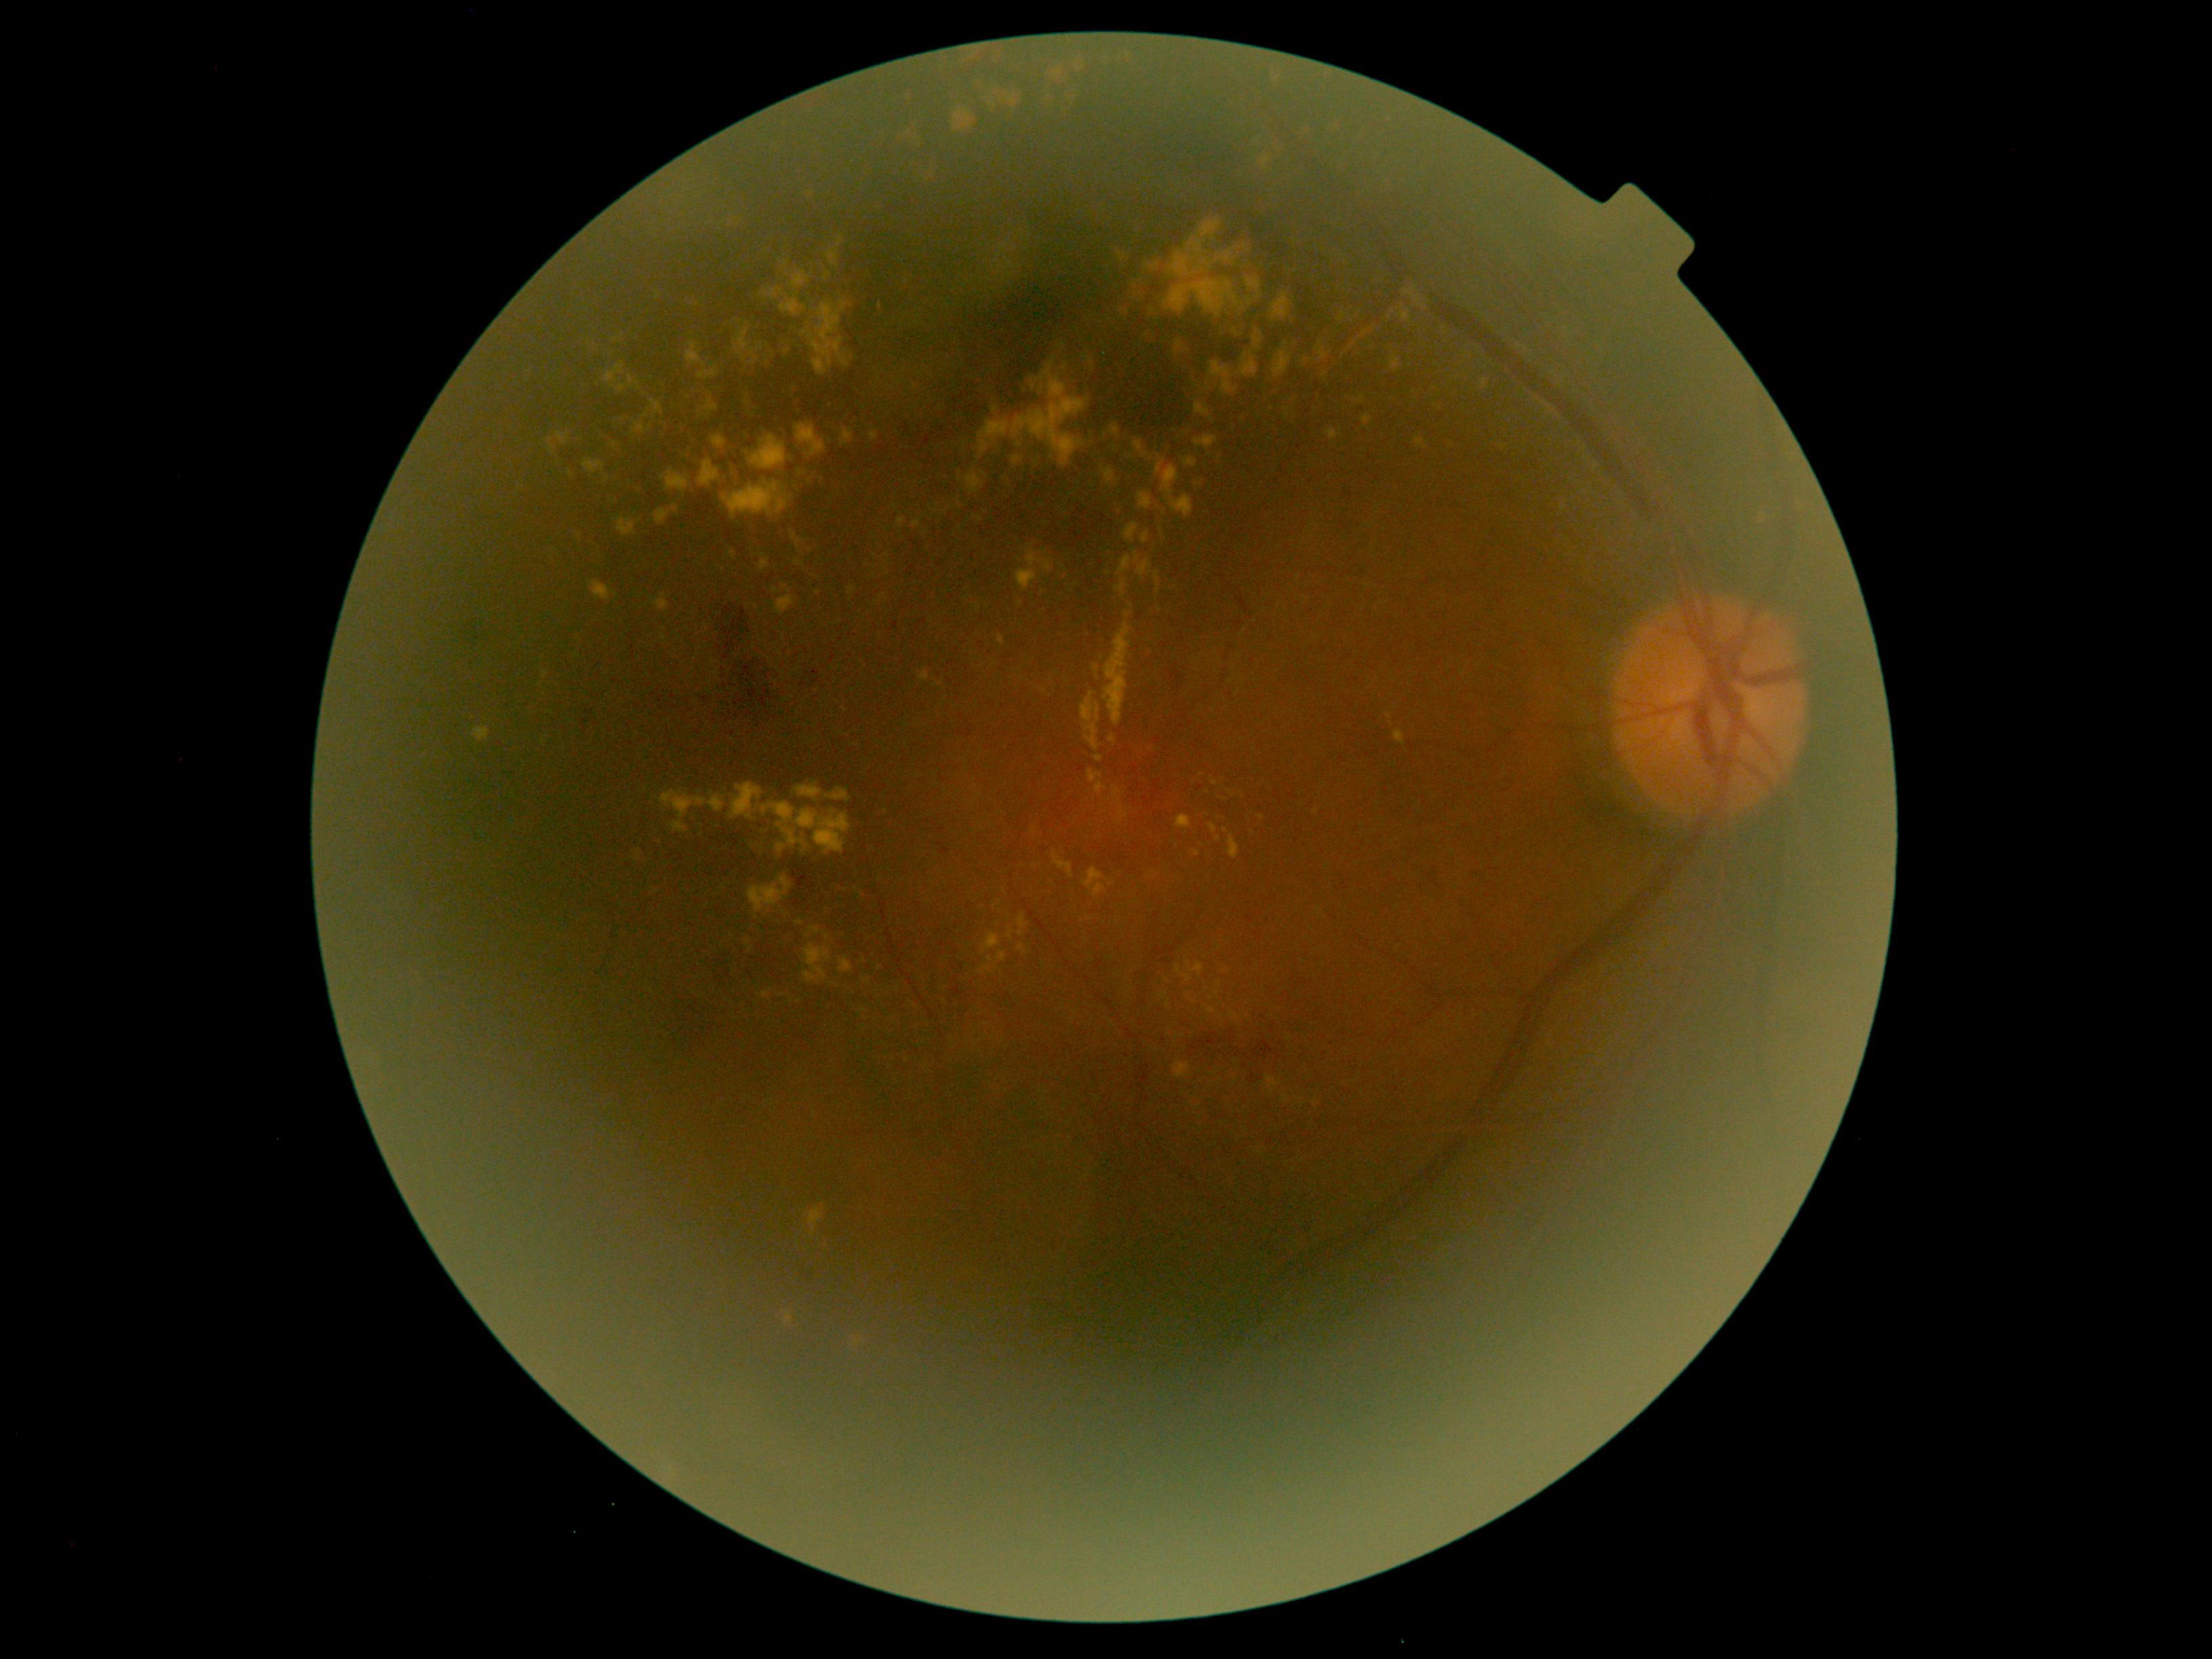 DR: 2/4
Representative lesions:
EXs (continued): (left=1193, top=434, right=1219, bottom=449), (left=704, top=626, right=710, bottom=634), (left=1230, top=1012, right=1240, bottom=1020), (left=746, top=395, right=752, bottom=406), (left=655, top=509, right=670, bottom=524), (left=1147, top=264, right=1160, bottom=272), (left=1229, top=836, right=1241, bottom=860), (left=1360, top=396, right=1364, bottom=405), (left=1210, top=361, right=1238, bottom=395), (left=1155, top=455, right=1193, bottom=517), (left=632, top=422, right=647, bottom=434), (left=1154, top=574, right=1161, bottom=593), (left=685, top=342, right=705, bottom=368)
Smaller EXs around point(792, 698), point(1178, 1038), point(717, 674), point(877, 603), point(646, 415), point(786, 265)